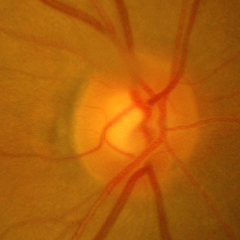 Q: What stage of glaucoma is present?
A: No glaucoma.